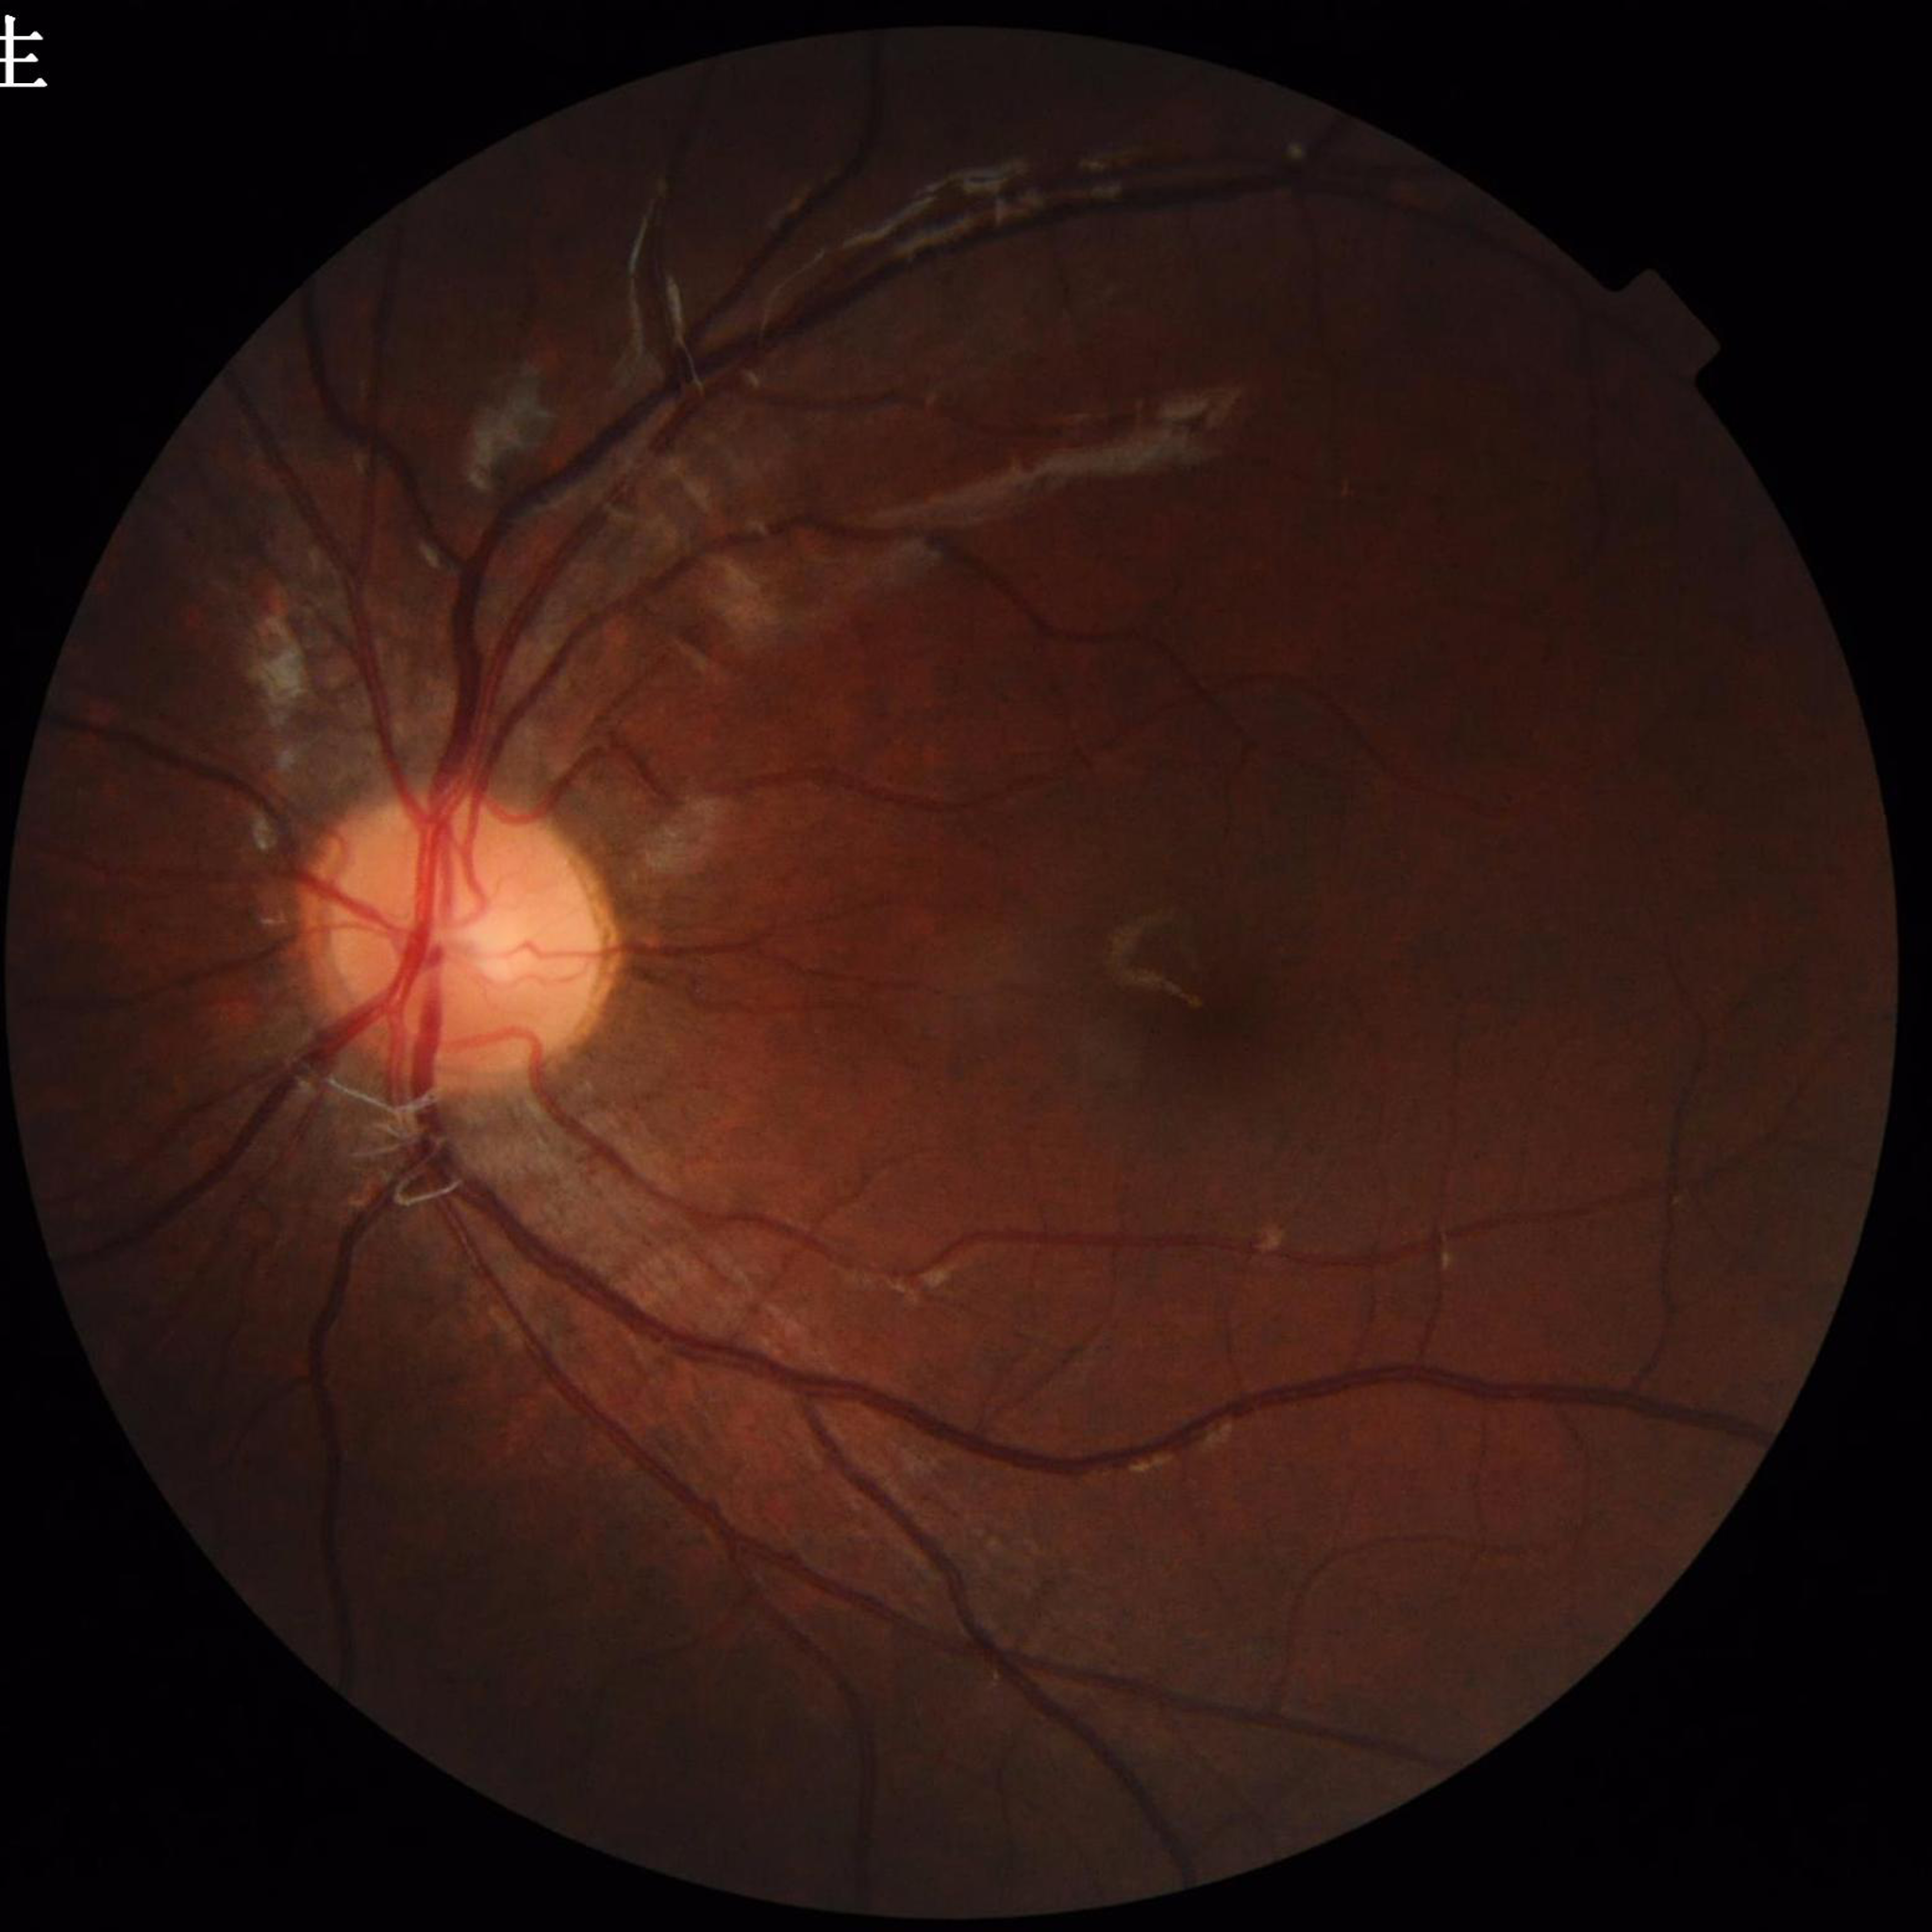 Disease: no AMD, DR, or glaucoma.